Fundus photo.
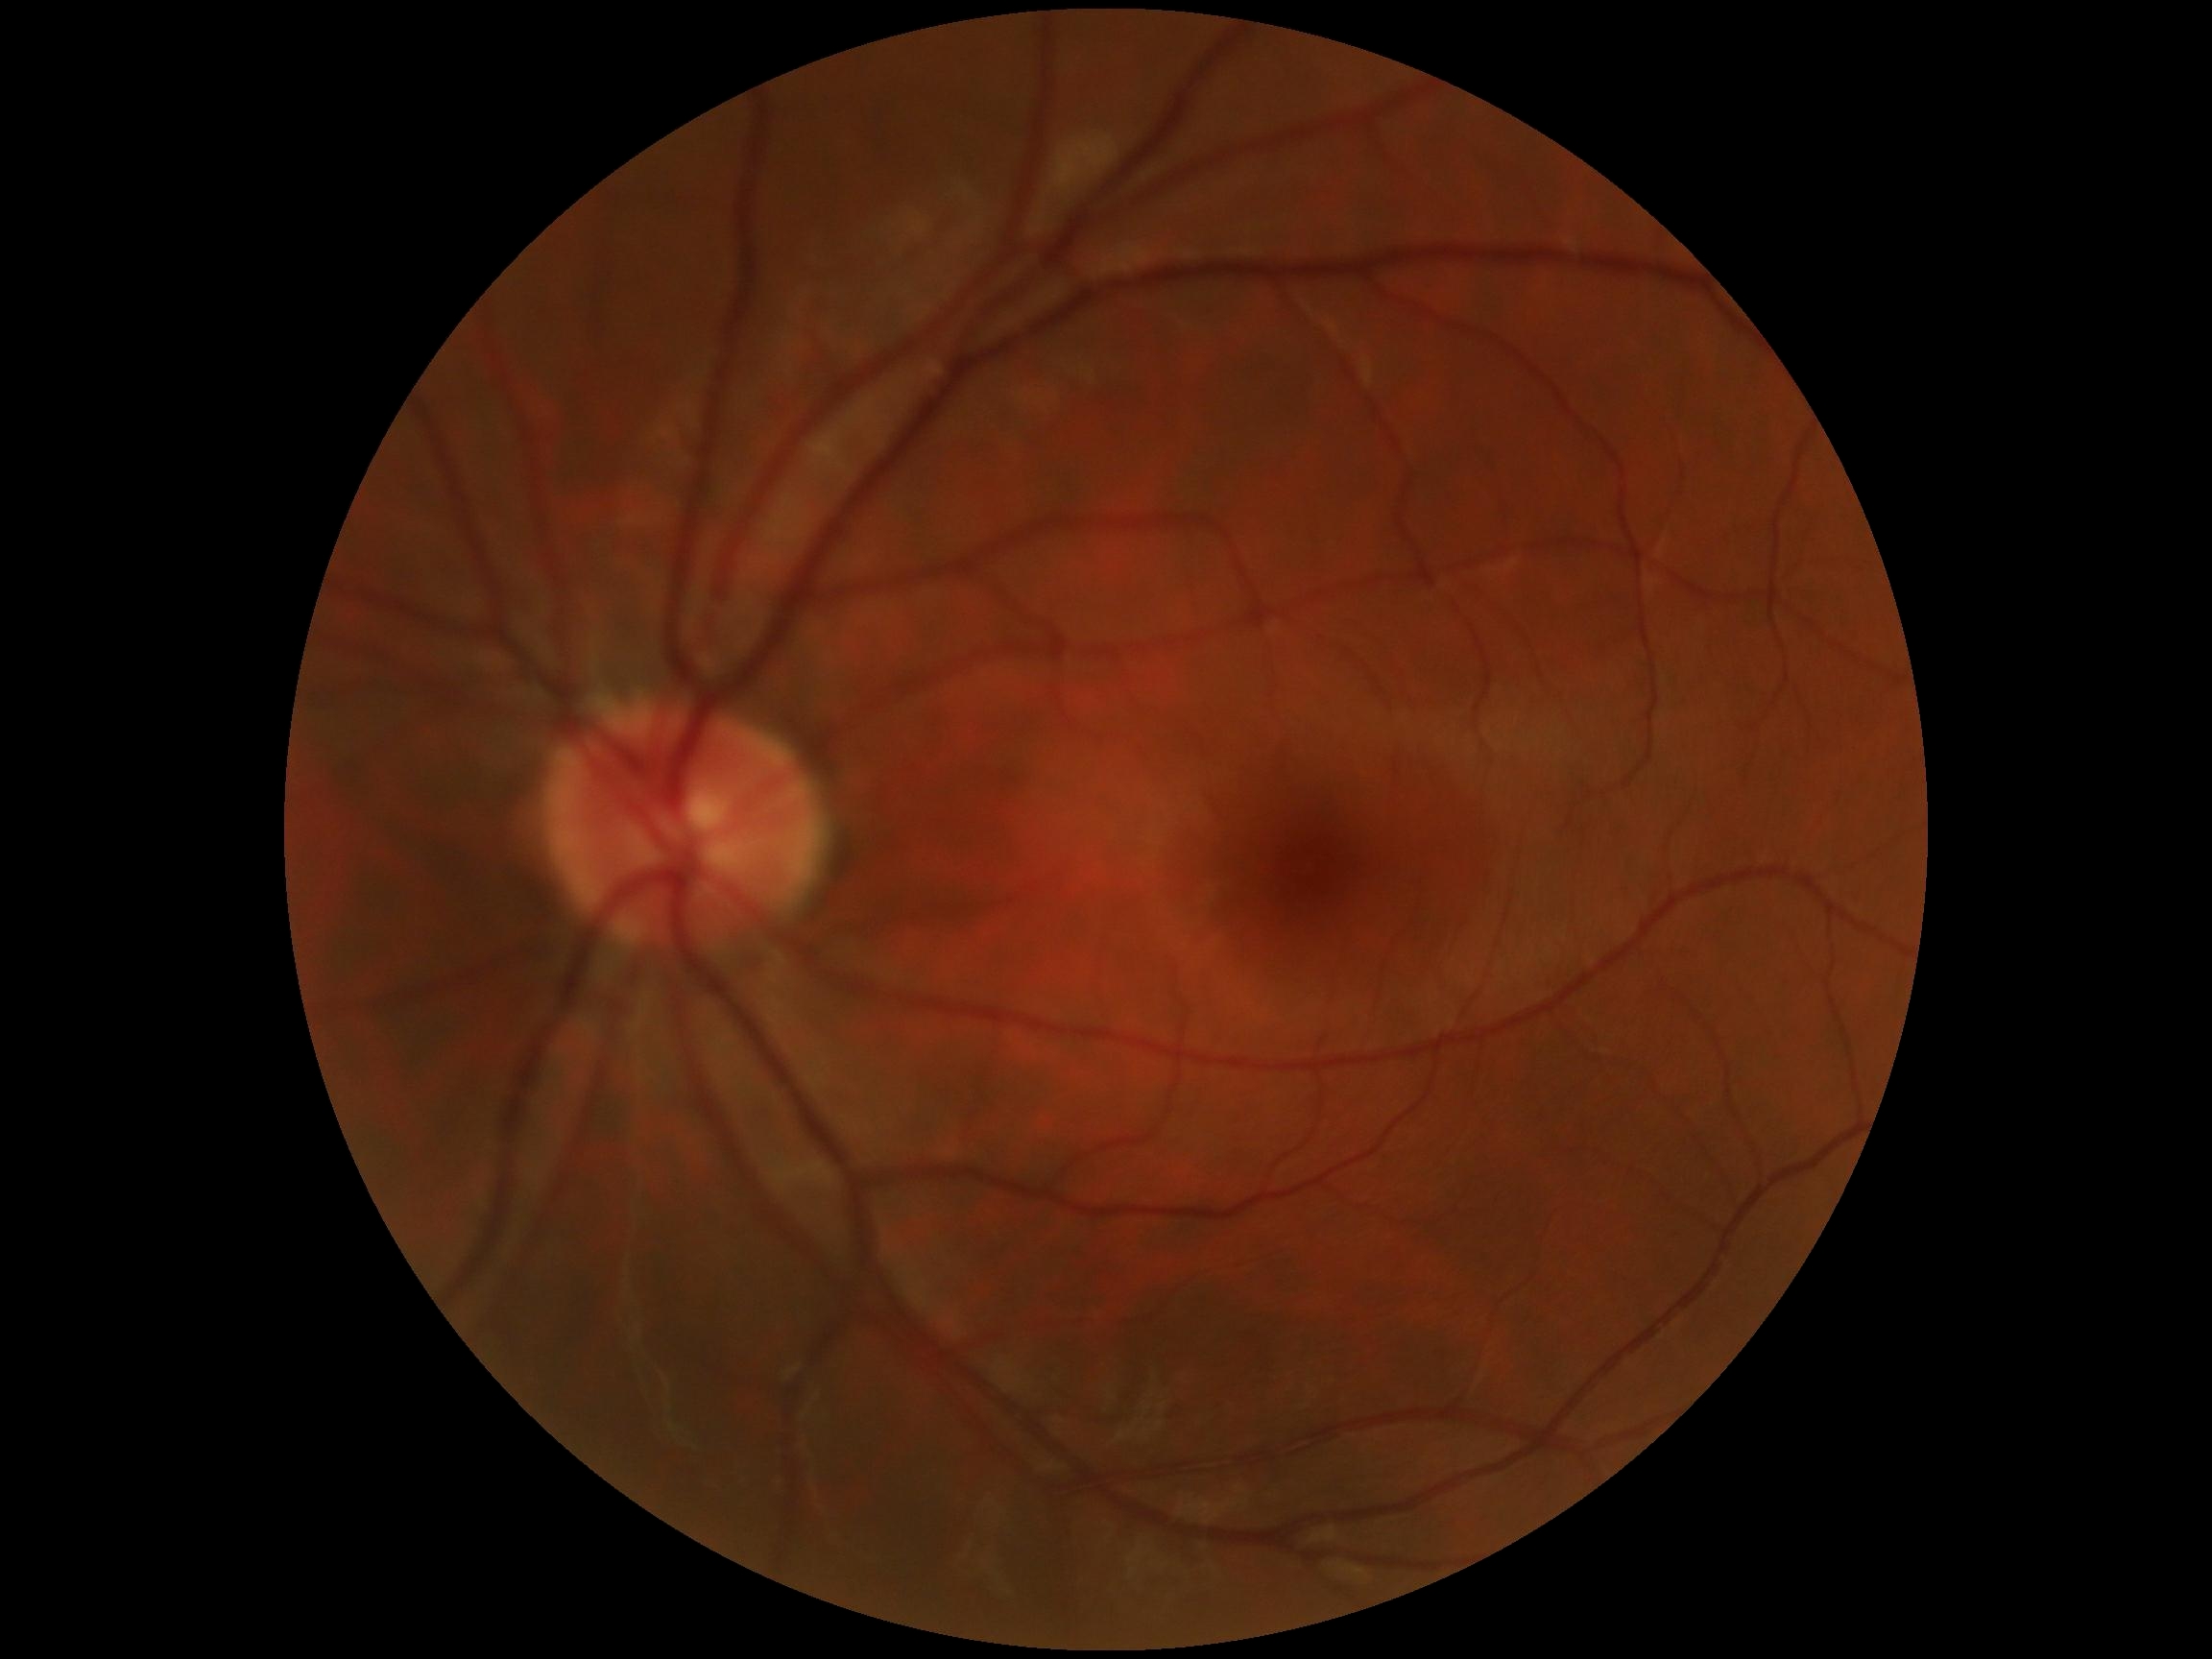 Annotations:
* DR stage: grade 0 (no apparent retinopathy)
* DR impression: no DR findings